2352x1568px — 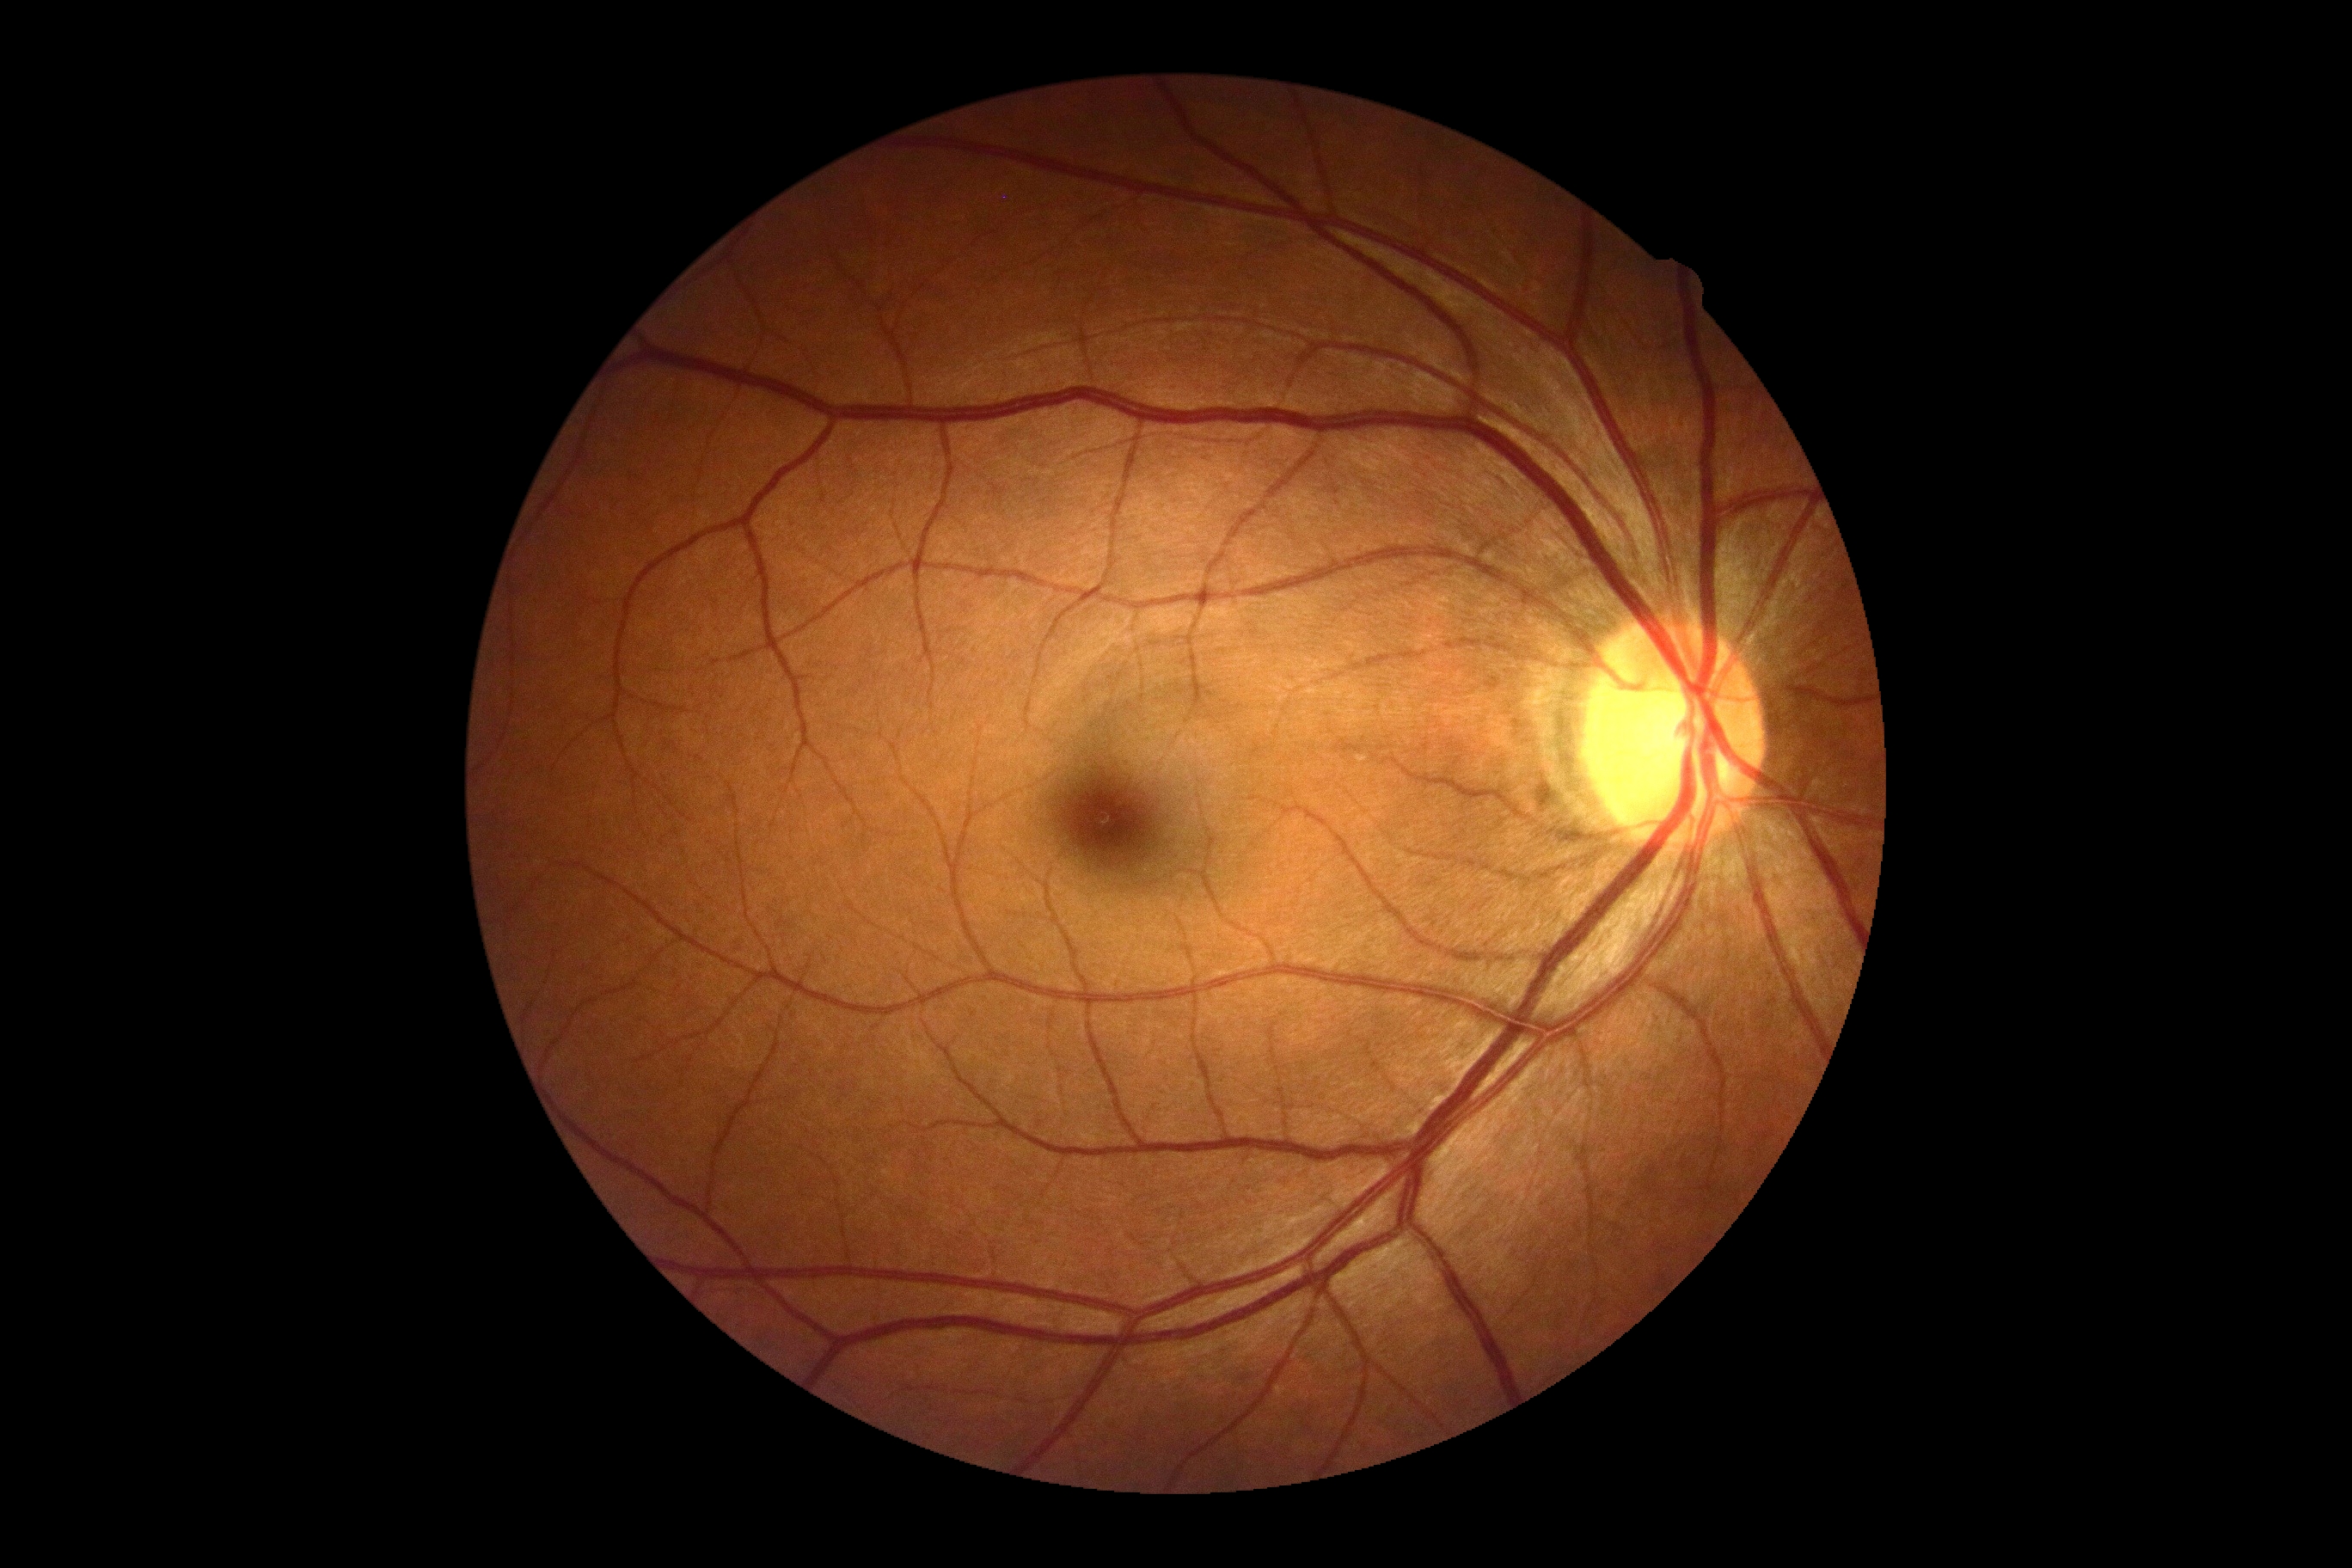
Diabetic retinopathy grade is 0/4.